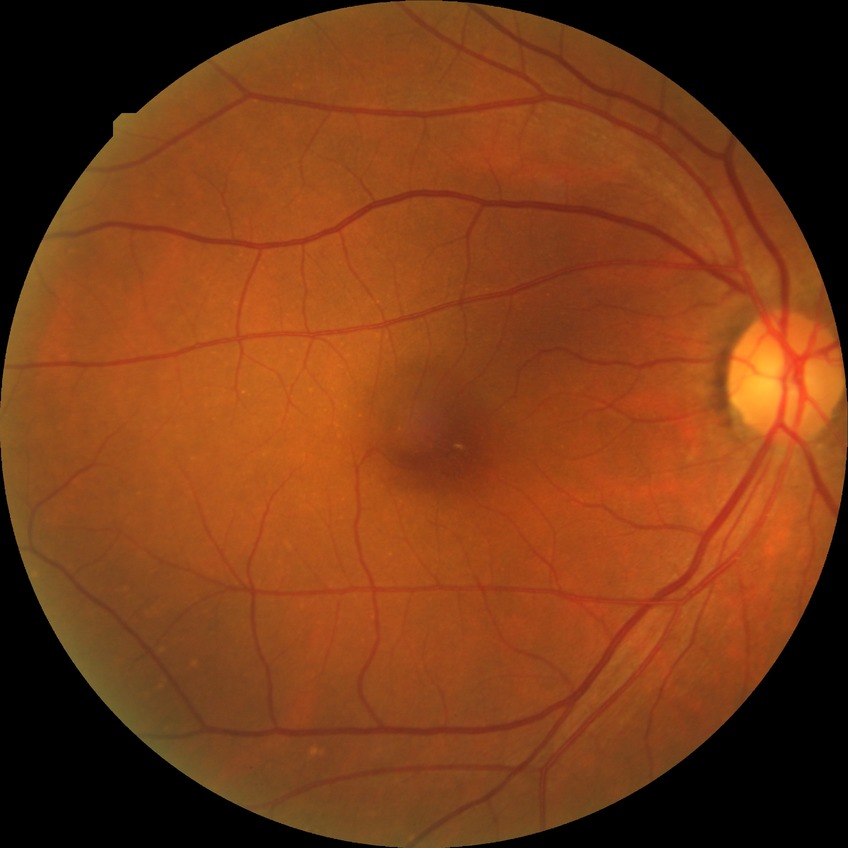
davis_grade: NDR (no diabetic retinopathy)